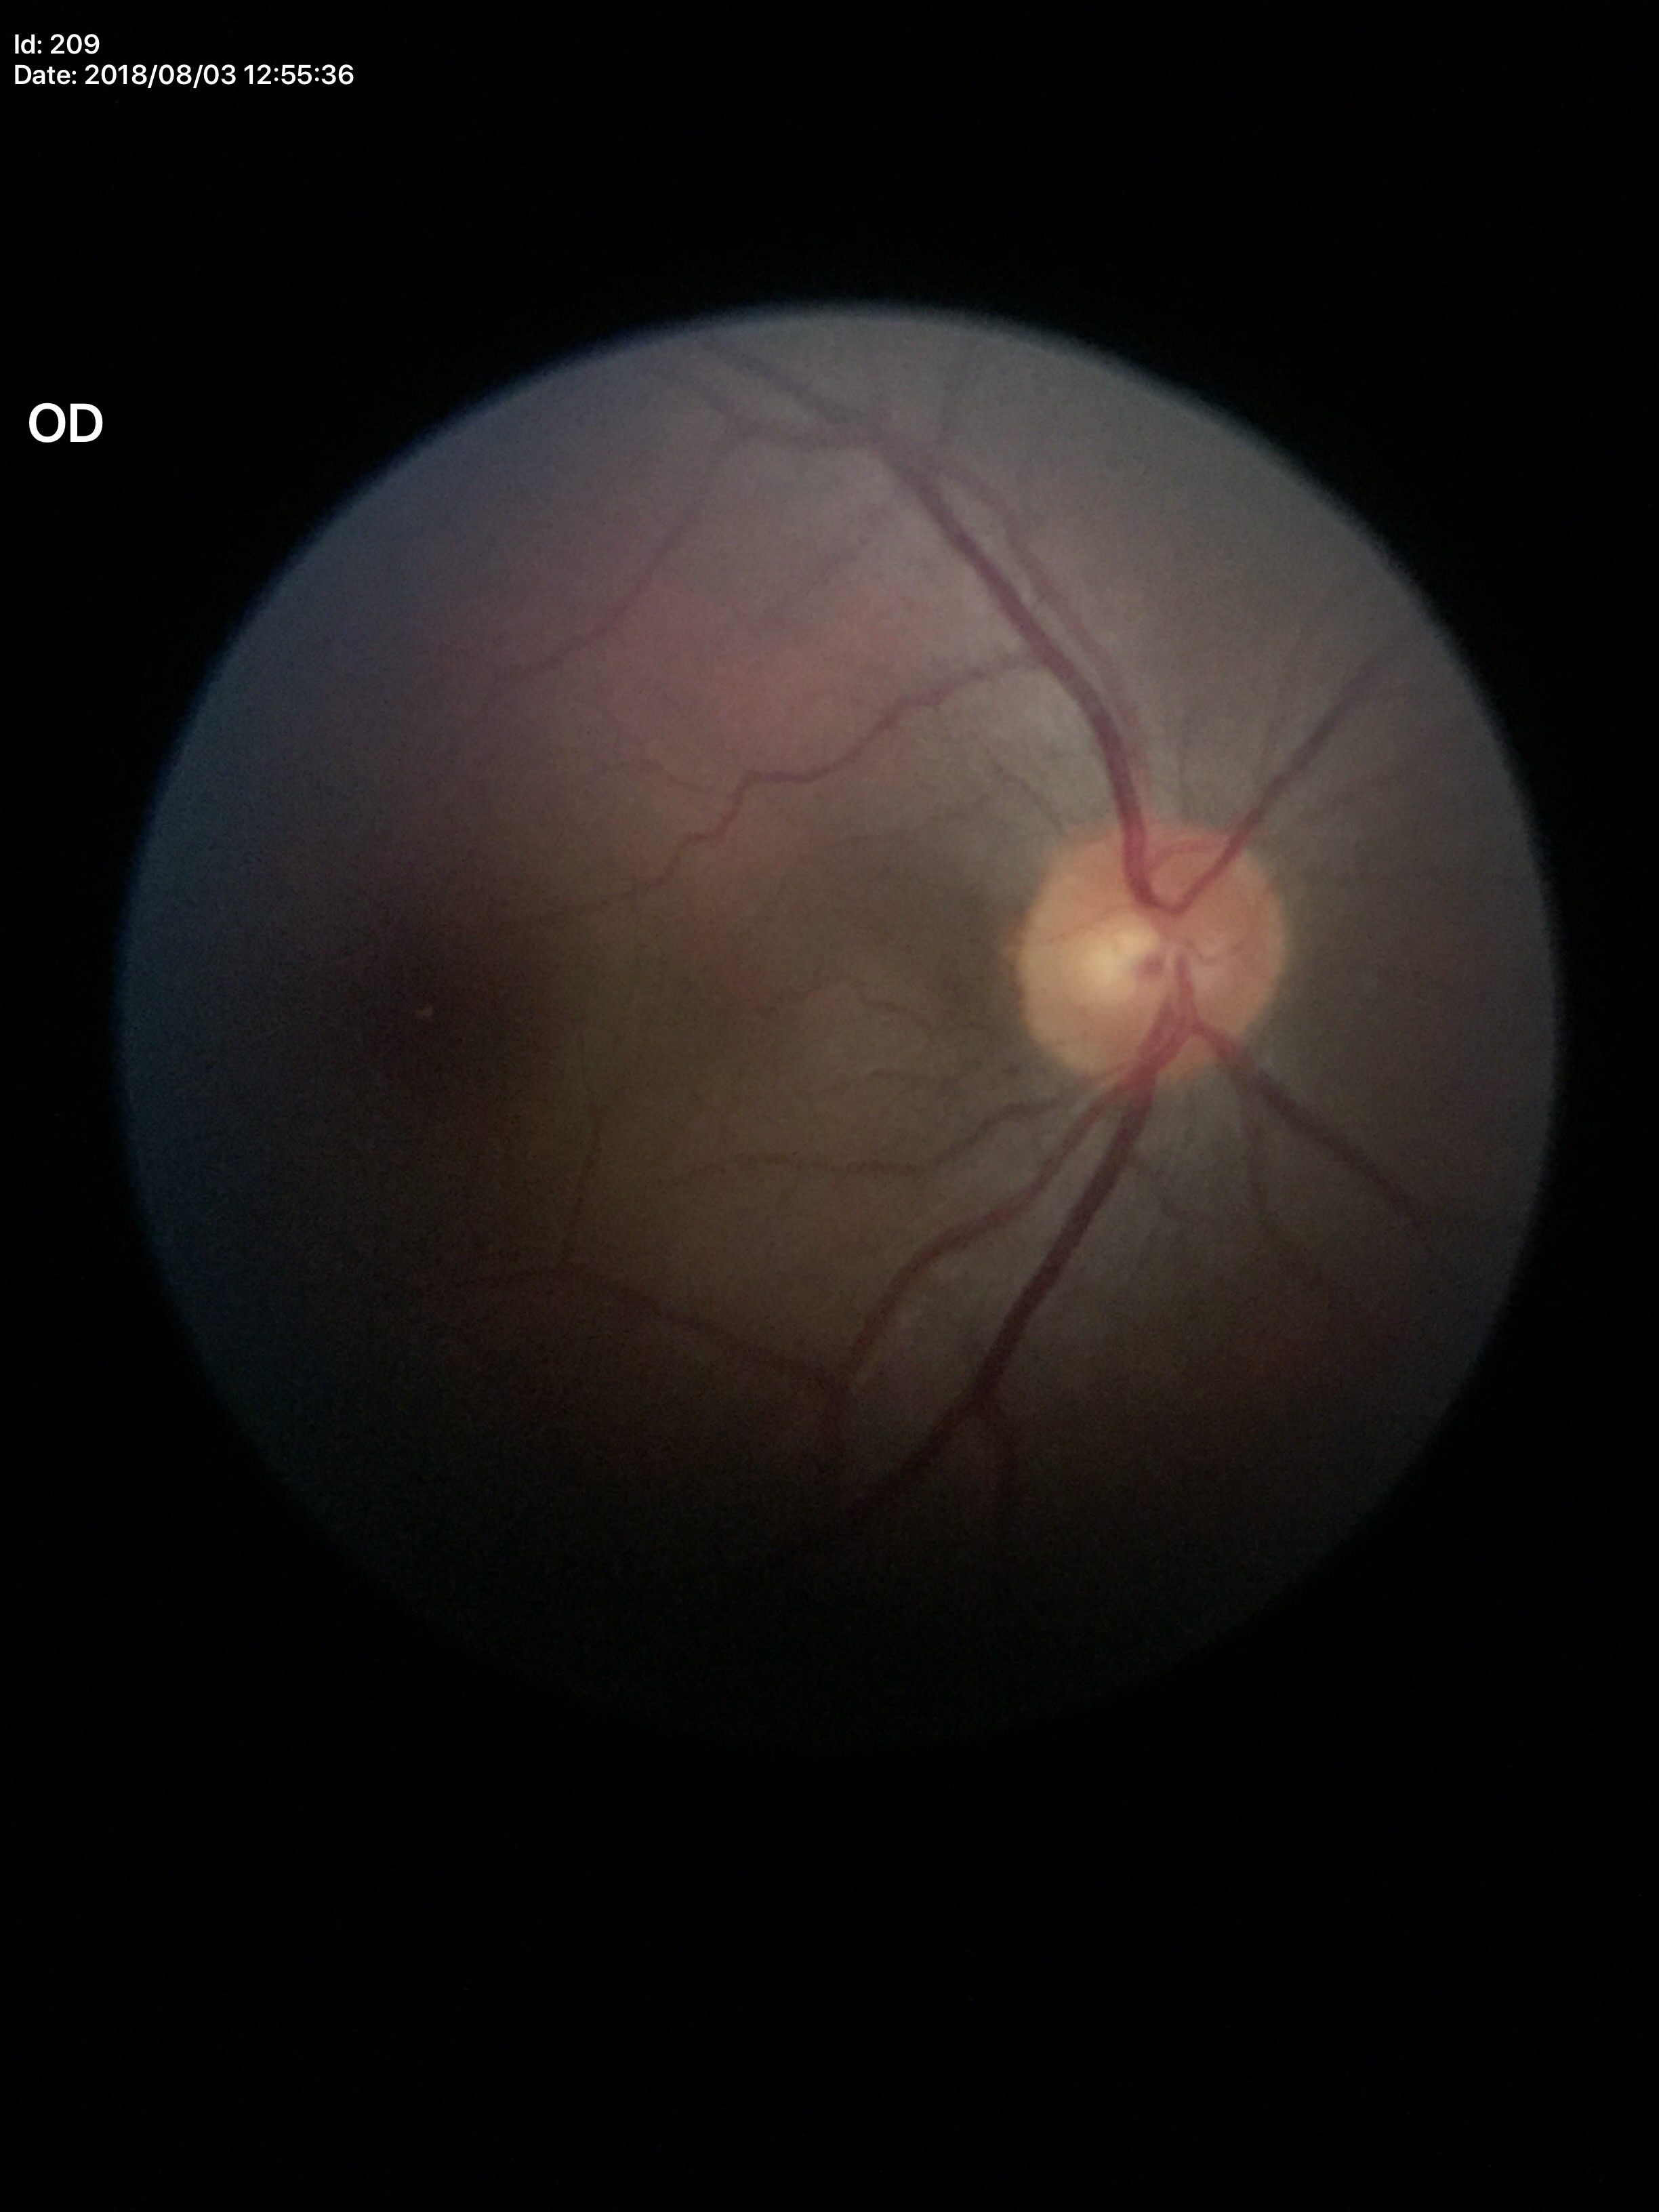 Q: What is the glaucoma assessment?
A: negative (5/5 ophthalmologists in agreement)
Q: What is the VCDR?
A: 0.41
Q: What is the horizontal cup-to-disc ratio?
A: 0.47